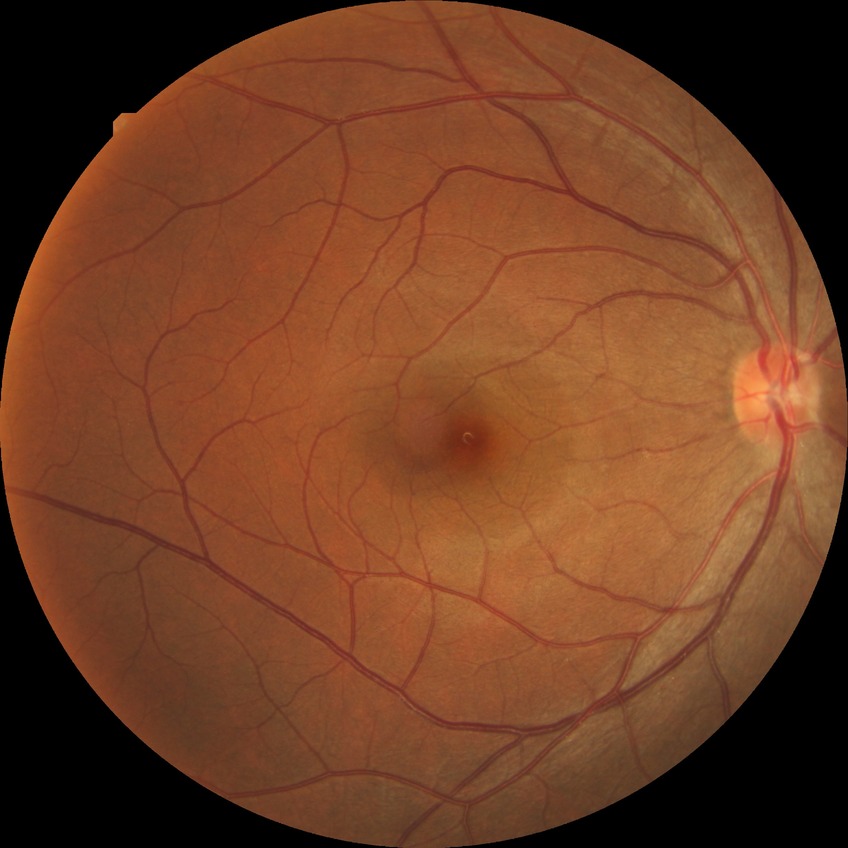

The retinopathy is classified as non-proliferative diabetic retinopathy. Diabetic retinopathy (DR): simple diabetic retinopathy (SDR).